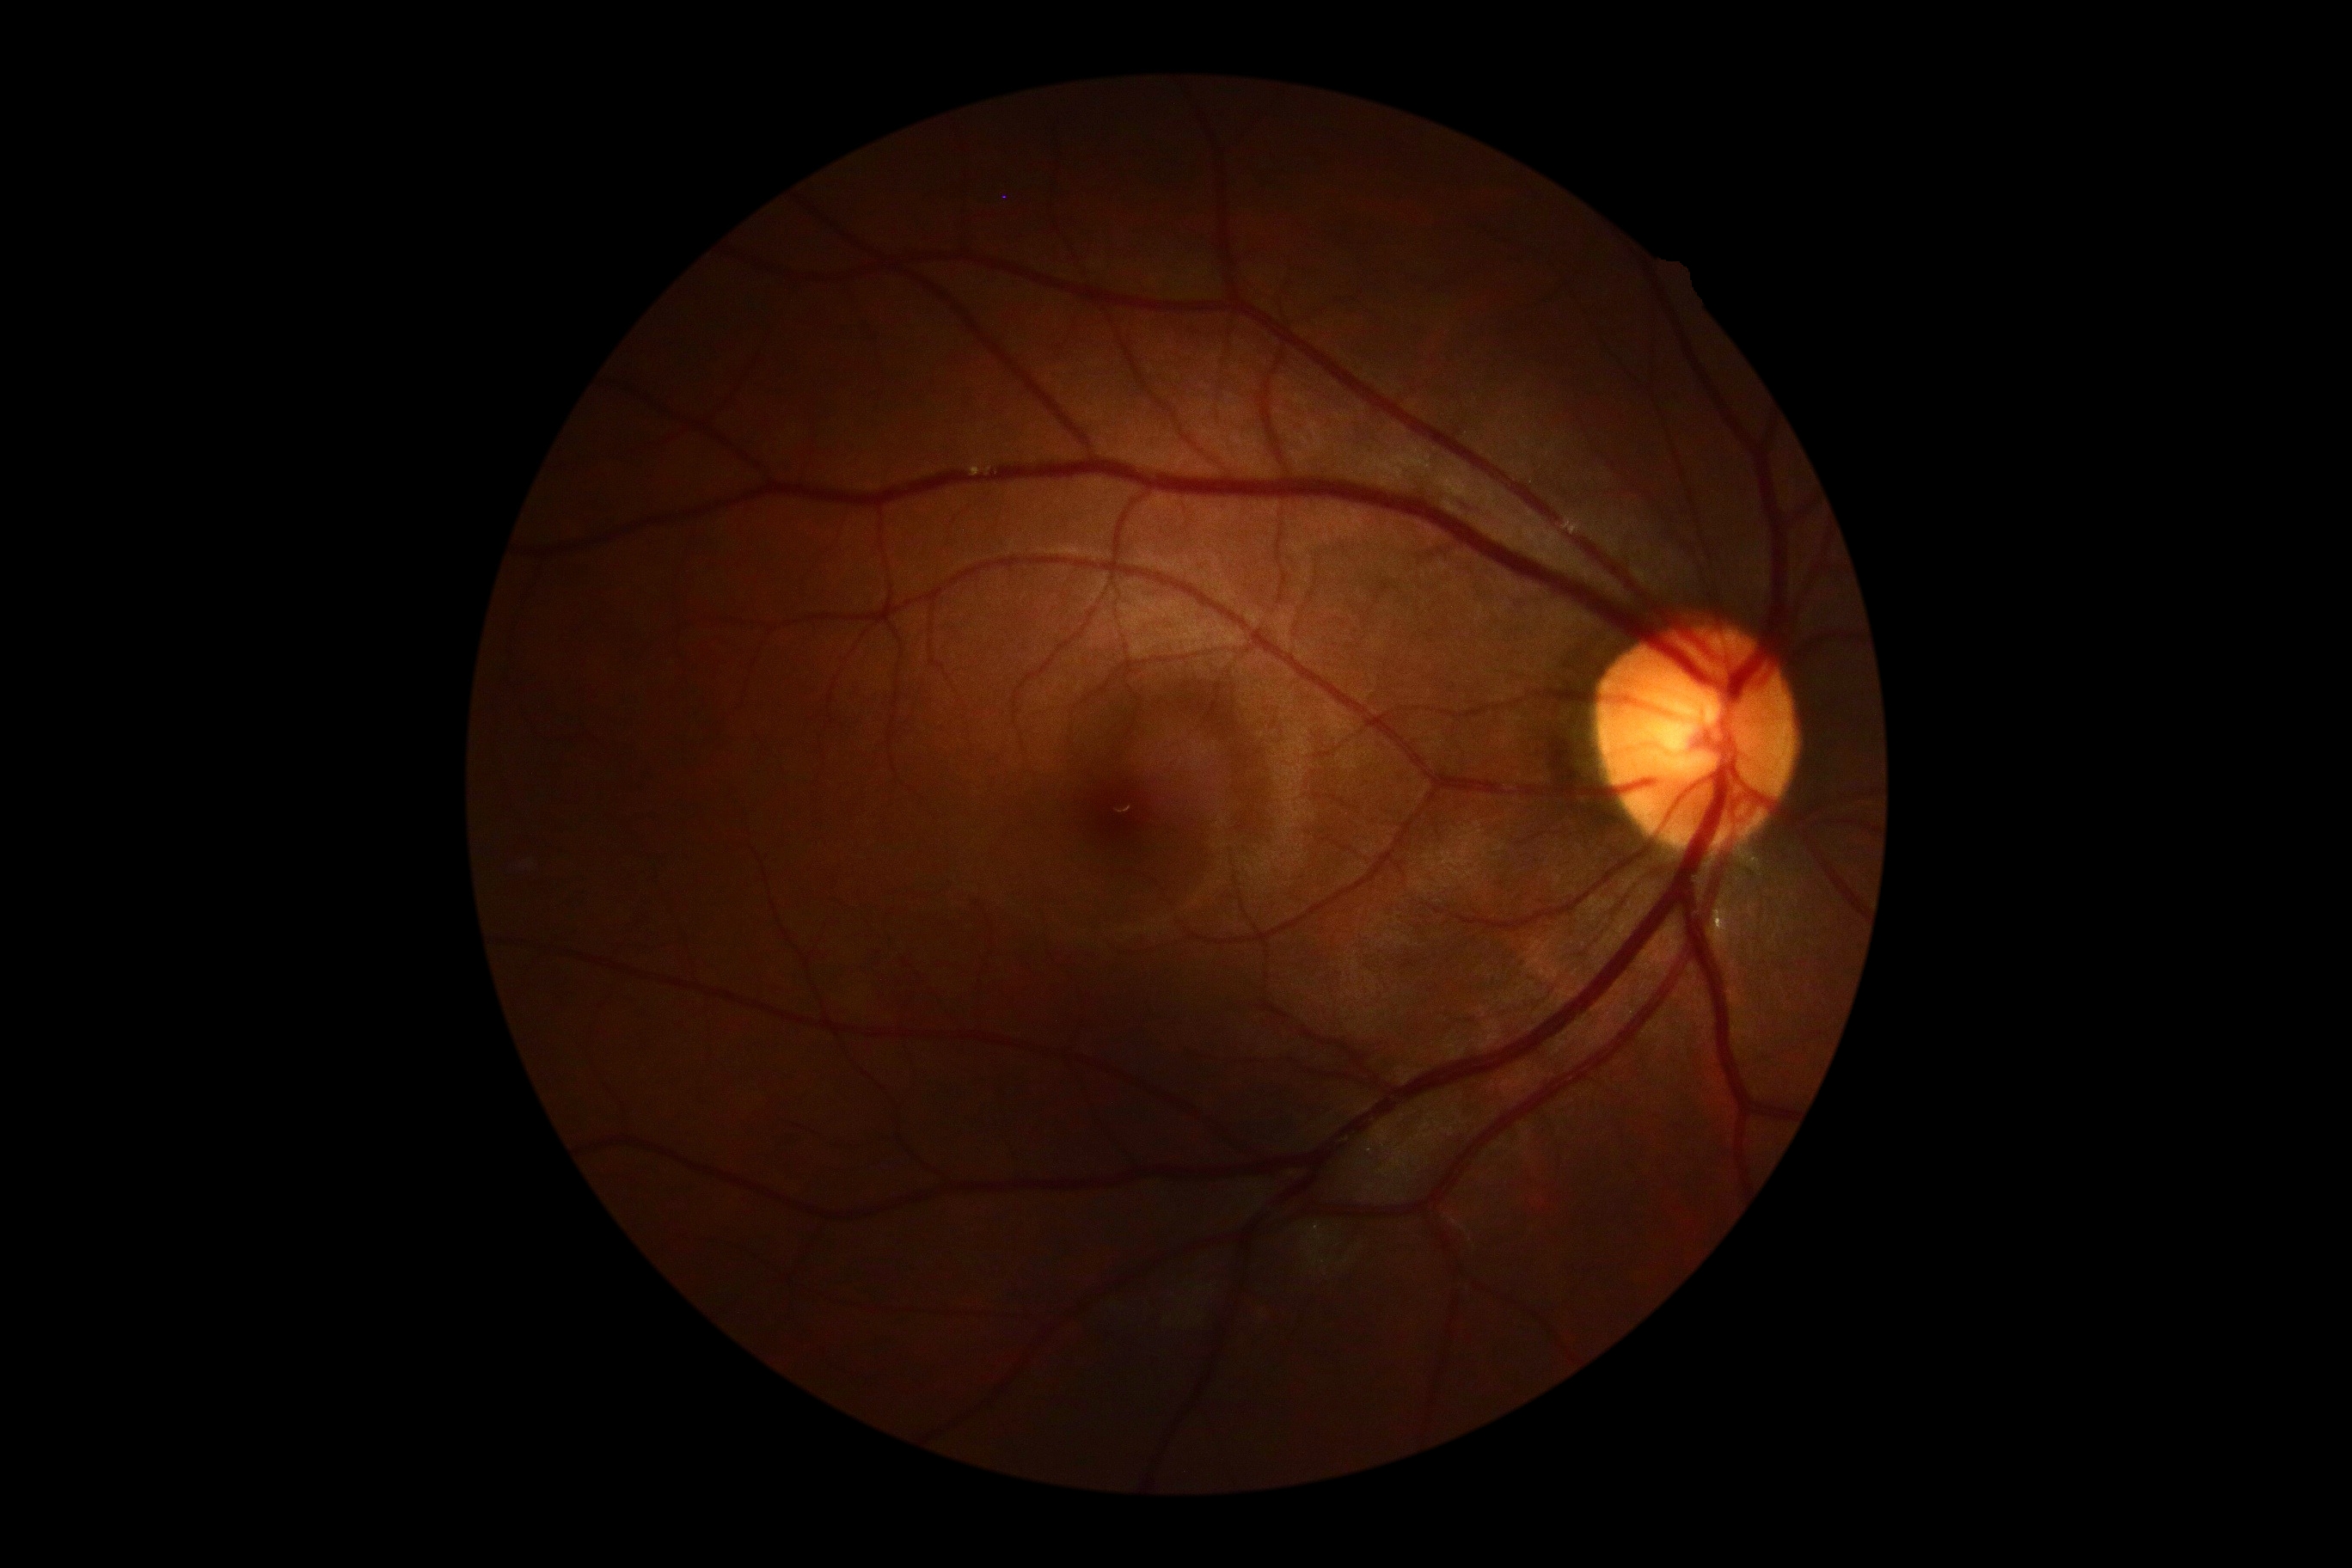

Diabetic retinopathy (DR) is no apparent diabetic retinopathy (grade 0) — no visible signs of diabetic retinopathy. No apparent diabetic retinopathy.